Camera: Phoenix ICON (100° FOV); wide-field fundus photograph from neonatal ROP screening:
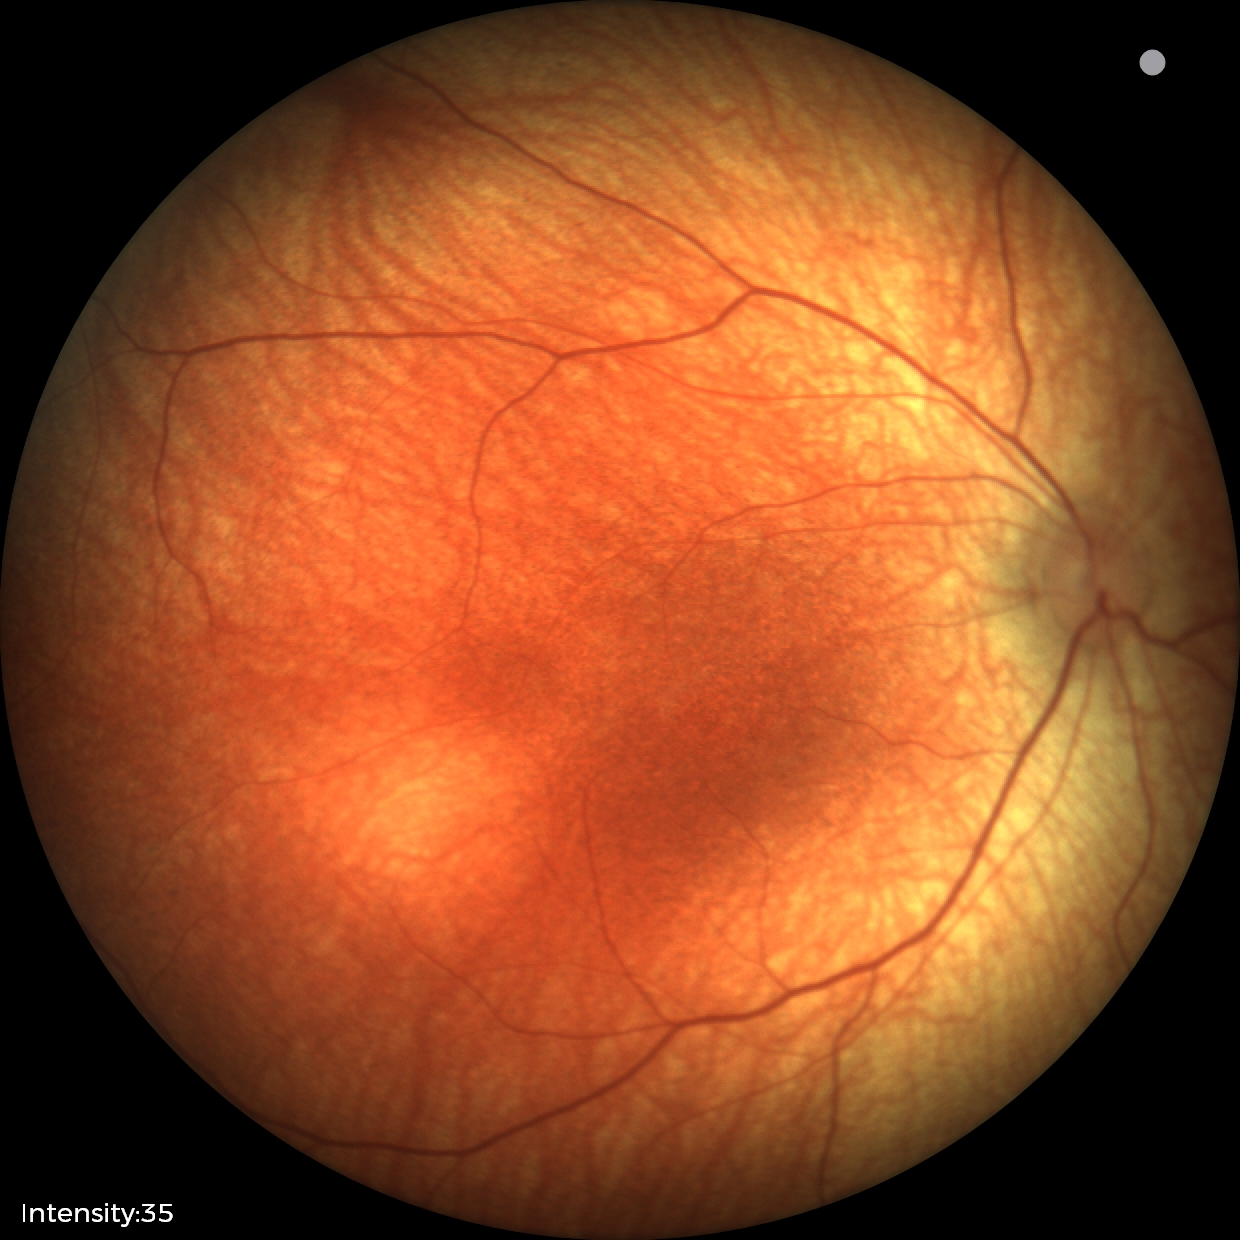

Physiological retinal appearance for postconceptual age.